Camera: NIDEK AFC-230; modified Davis grading; retinal fundus photograph:
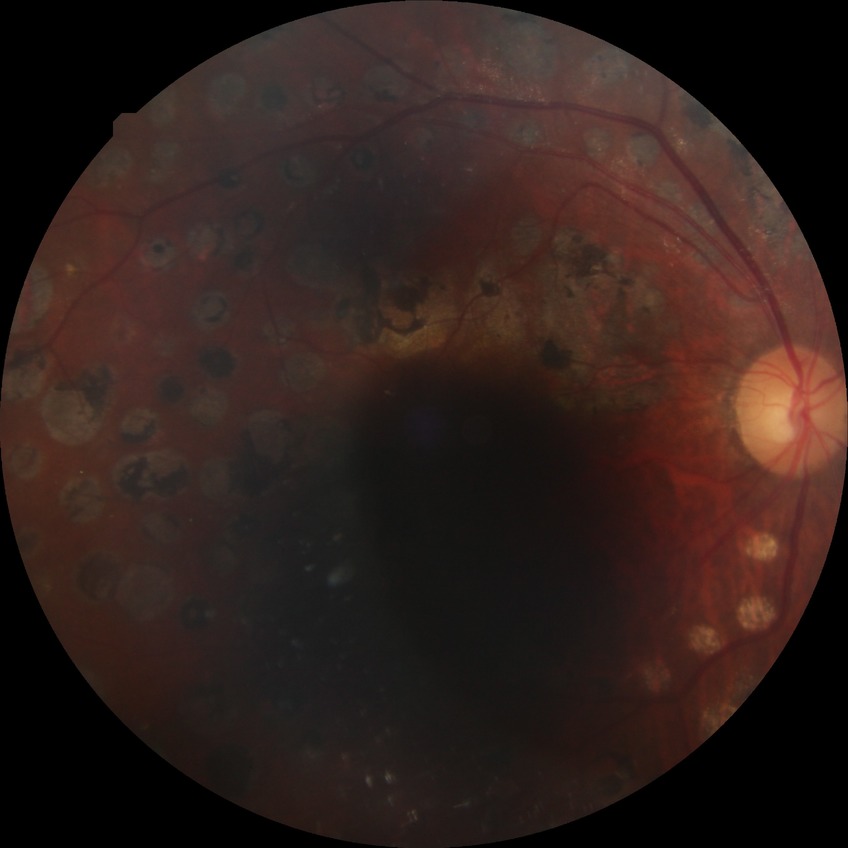 Diabetic retinopathy (DR): PDR (proliferative diabetic retinopathy).